640x480. RetCam wide-field infant fundus image — 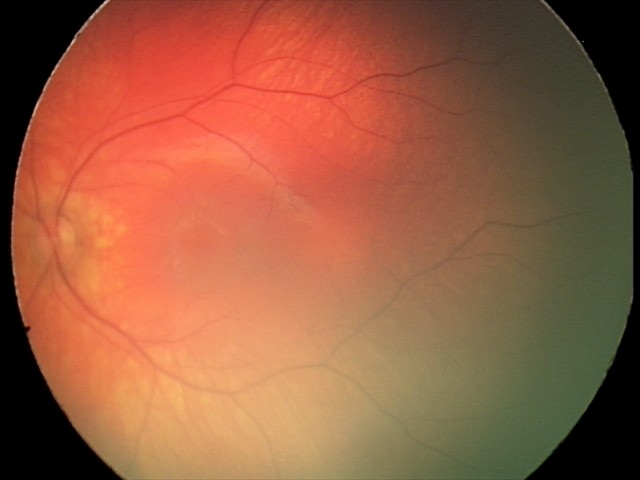 Screening examination diagnosed as physiological.